Portable fundus camera image · 2212 x 1659 pixels:
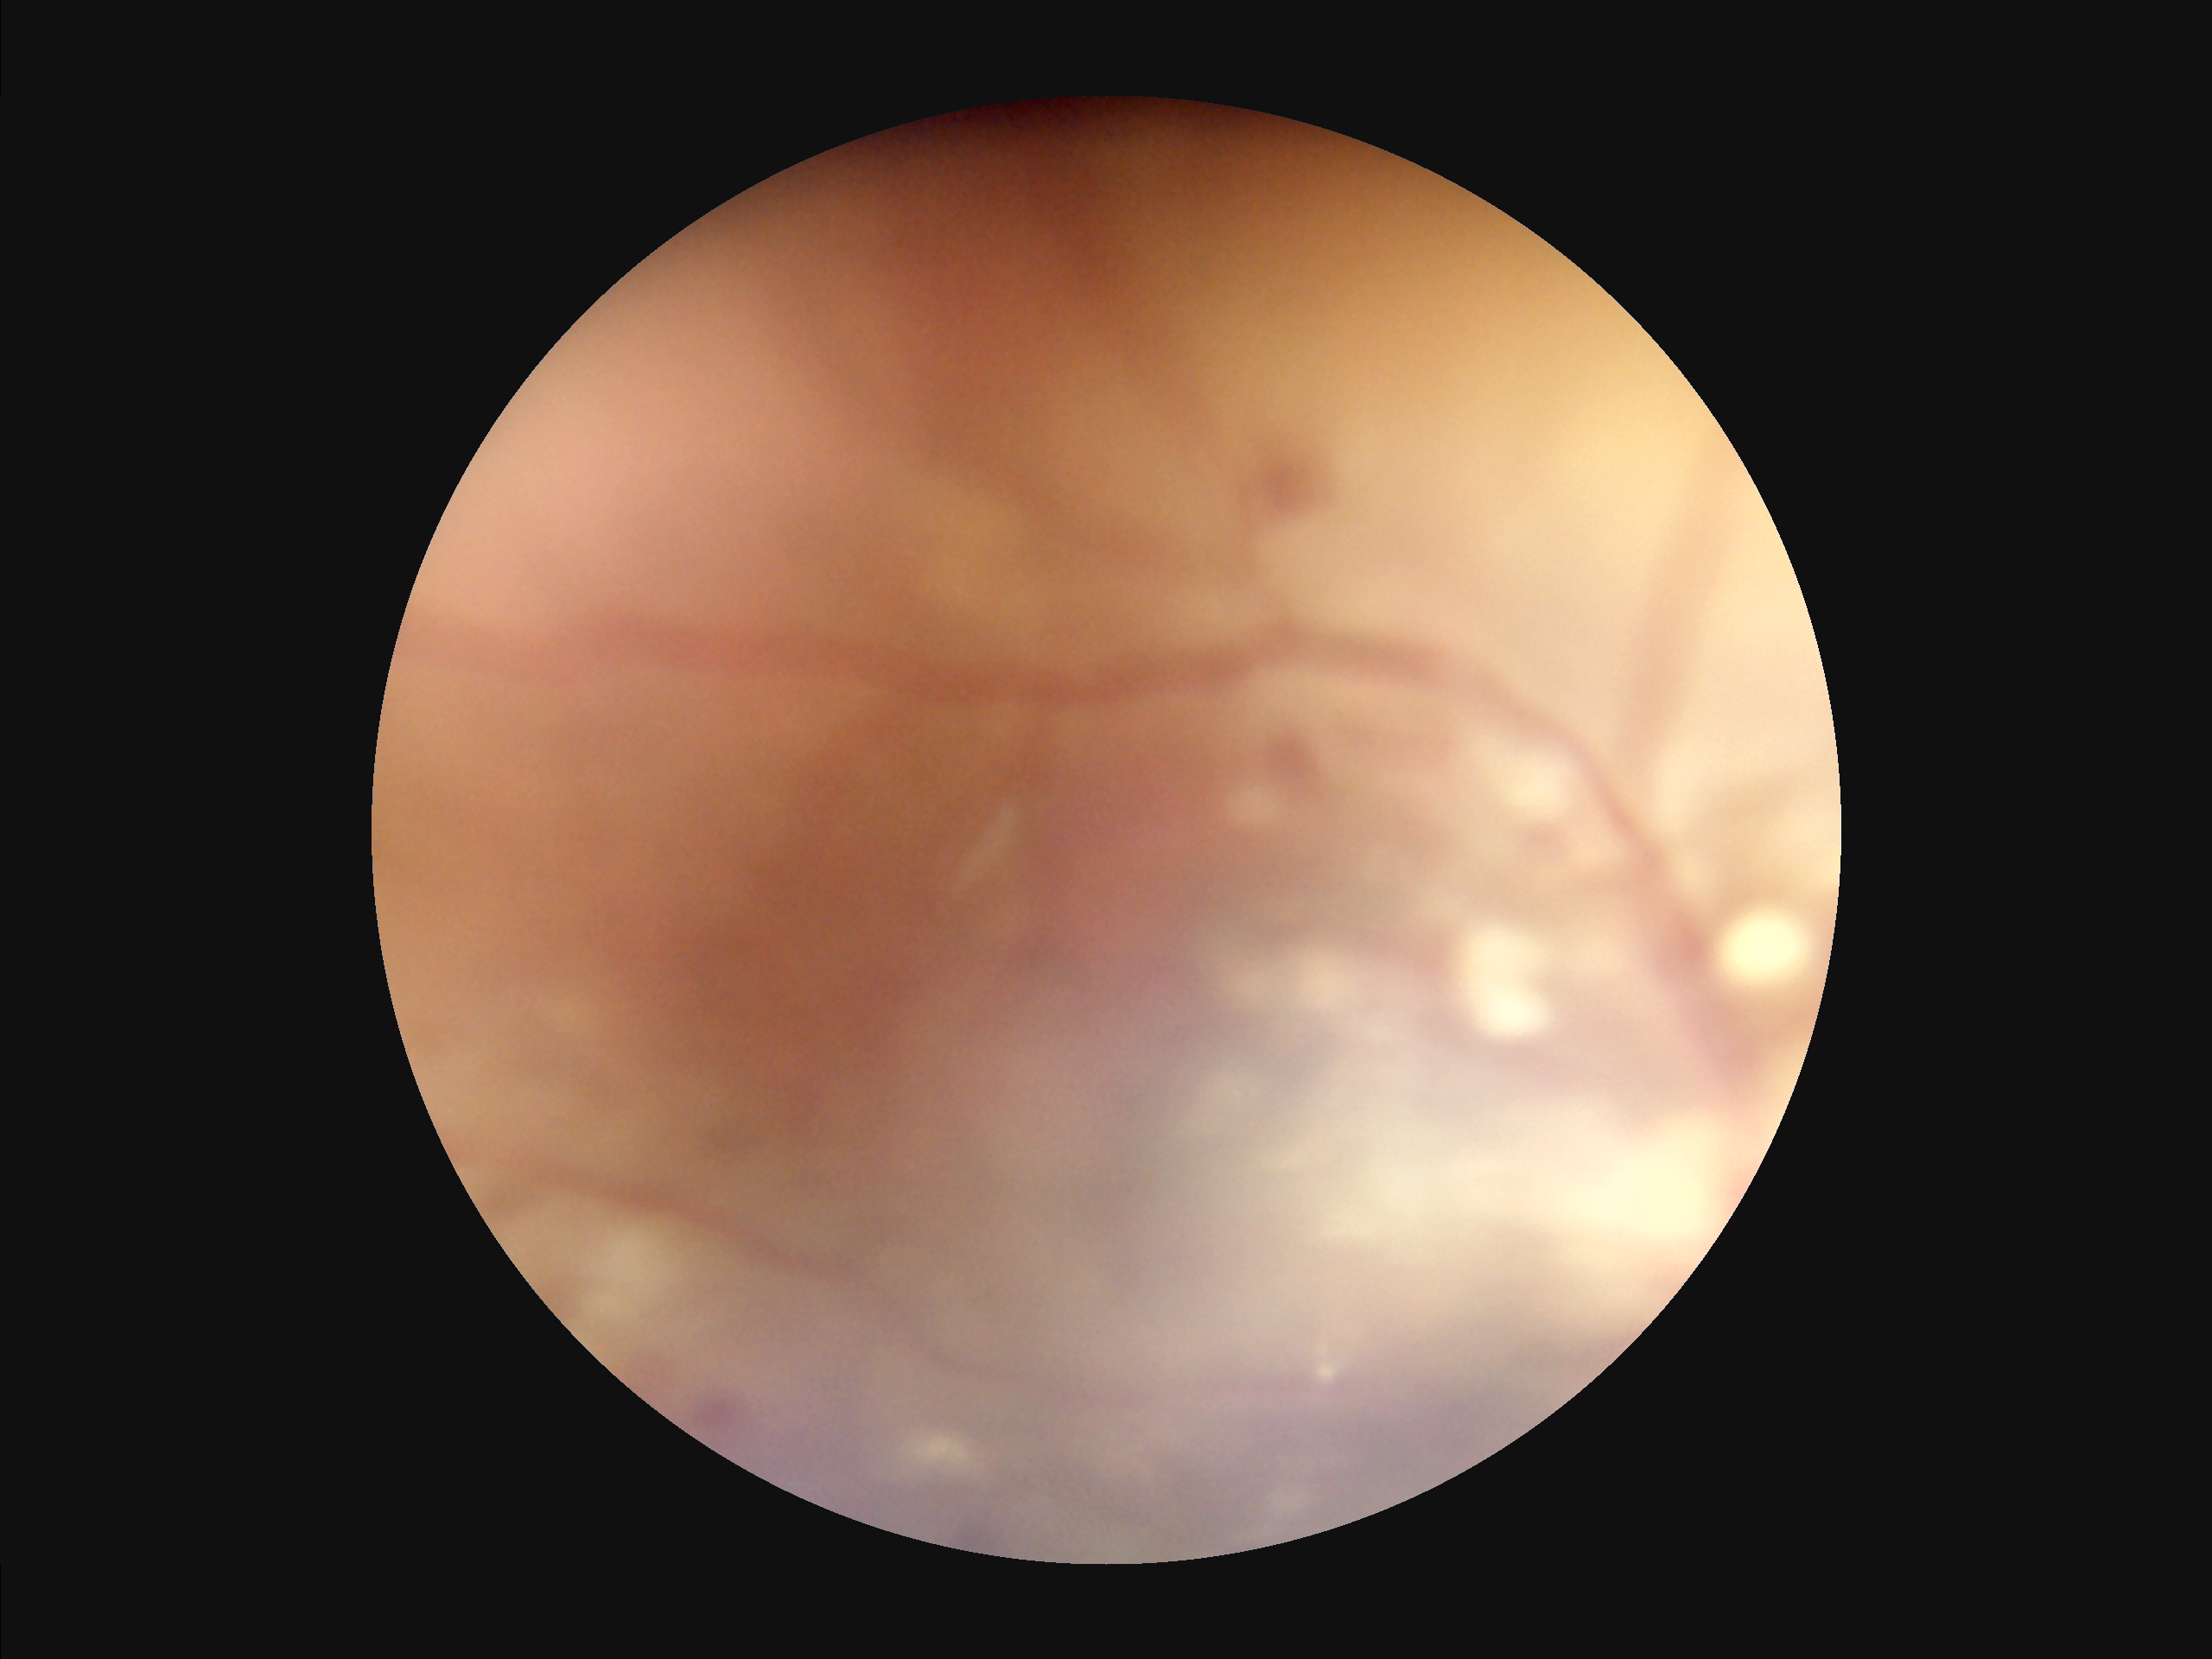

Overall image quality is poor. Poor dynamic range. Reduced sharpness with visible blur. Illumination is uneven.